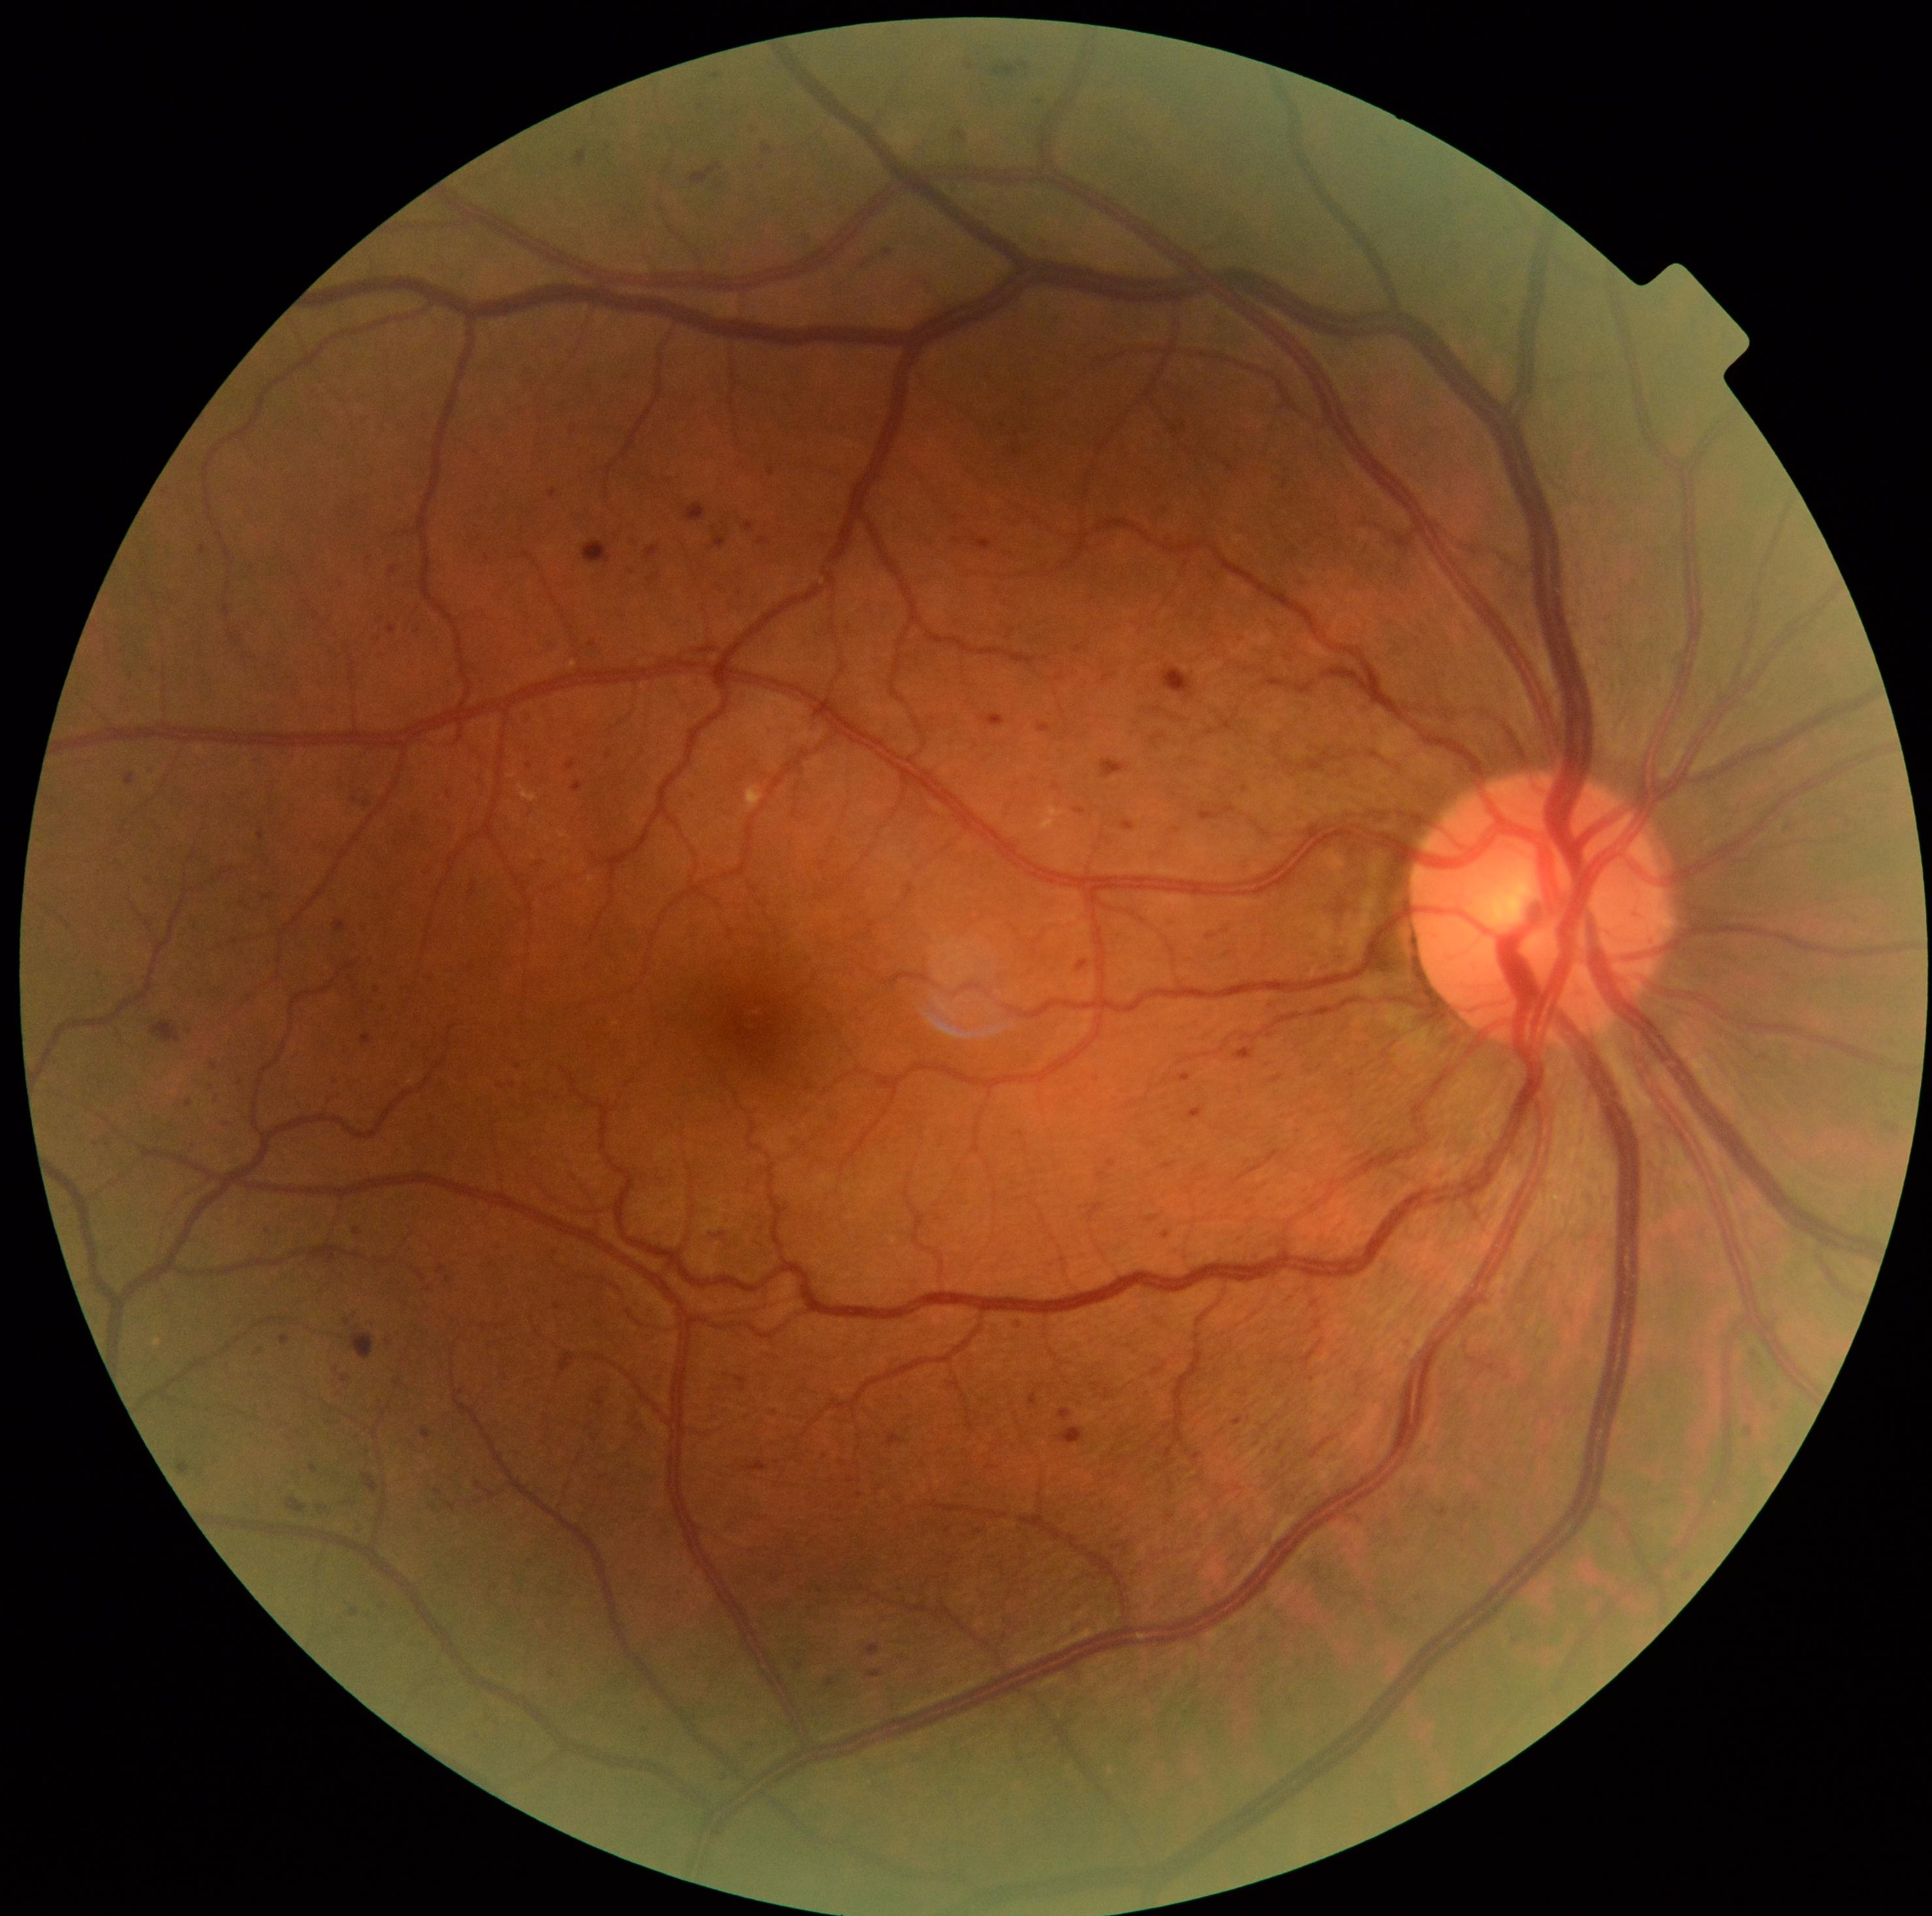
DR: grade 3 (severe NPDR).